Pediatric retinal photograph (wide-field) · 640 by 480 pixels · 130° field of view (Clarity RetCam 3) — 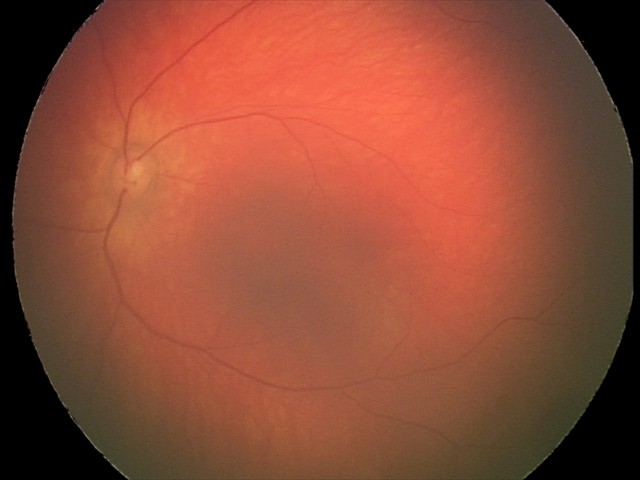

From an examination with diagnosis of retinal hemorrhages.